Color fundus image; 2352 x 1568 pixels: 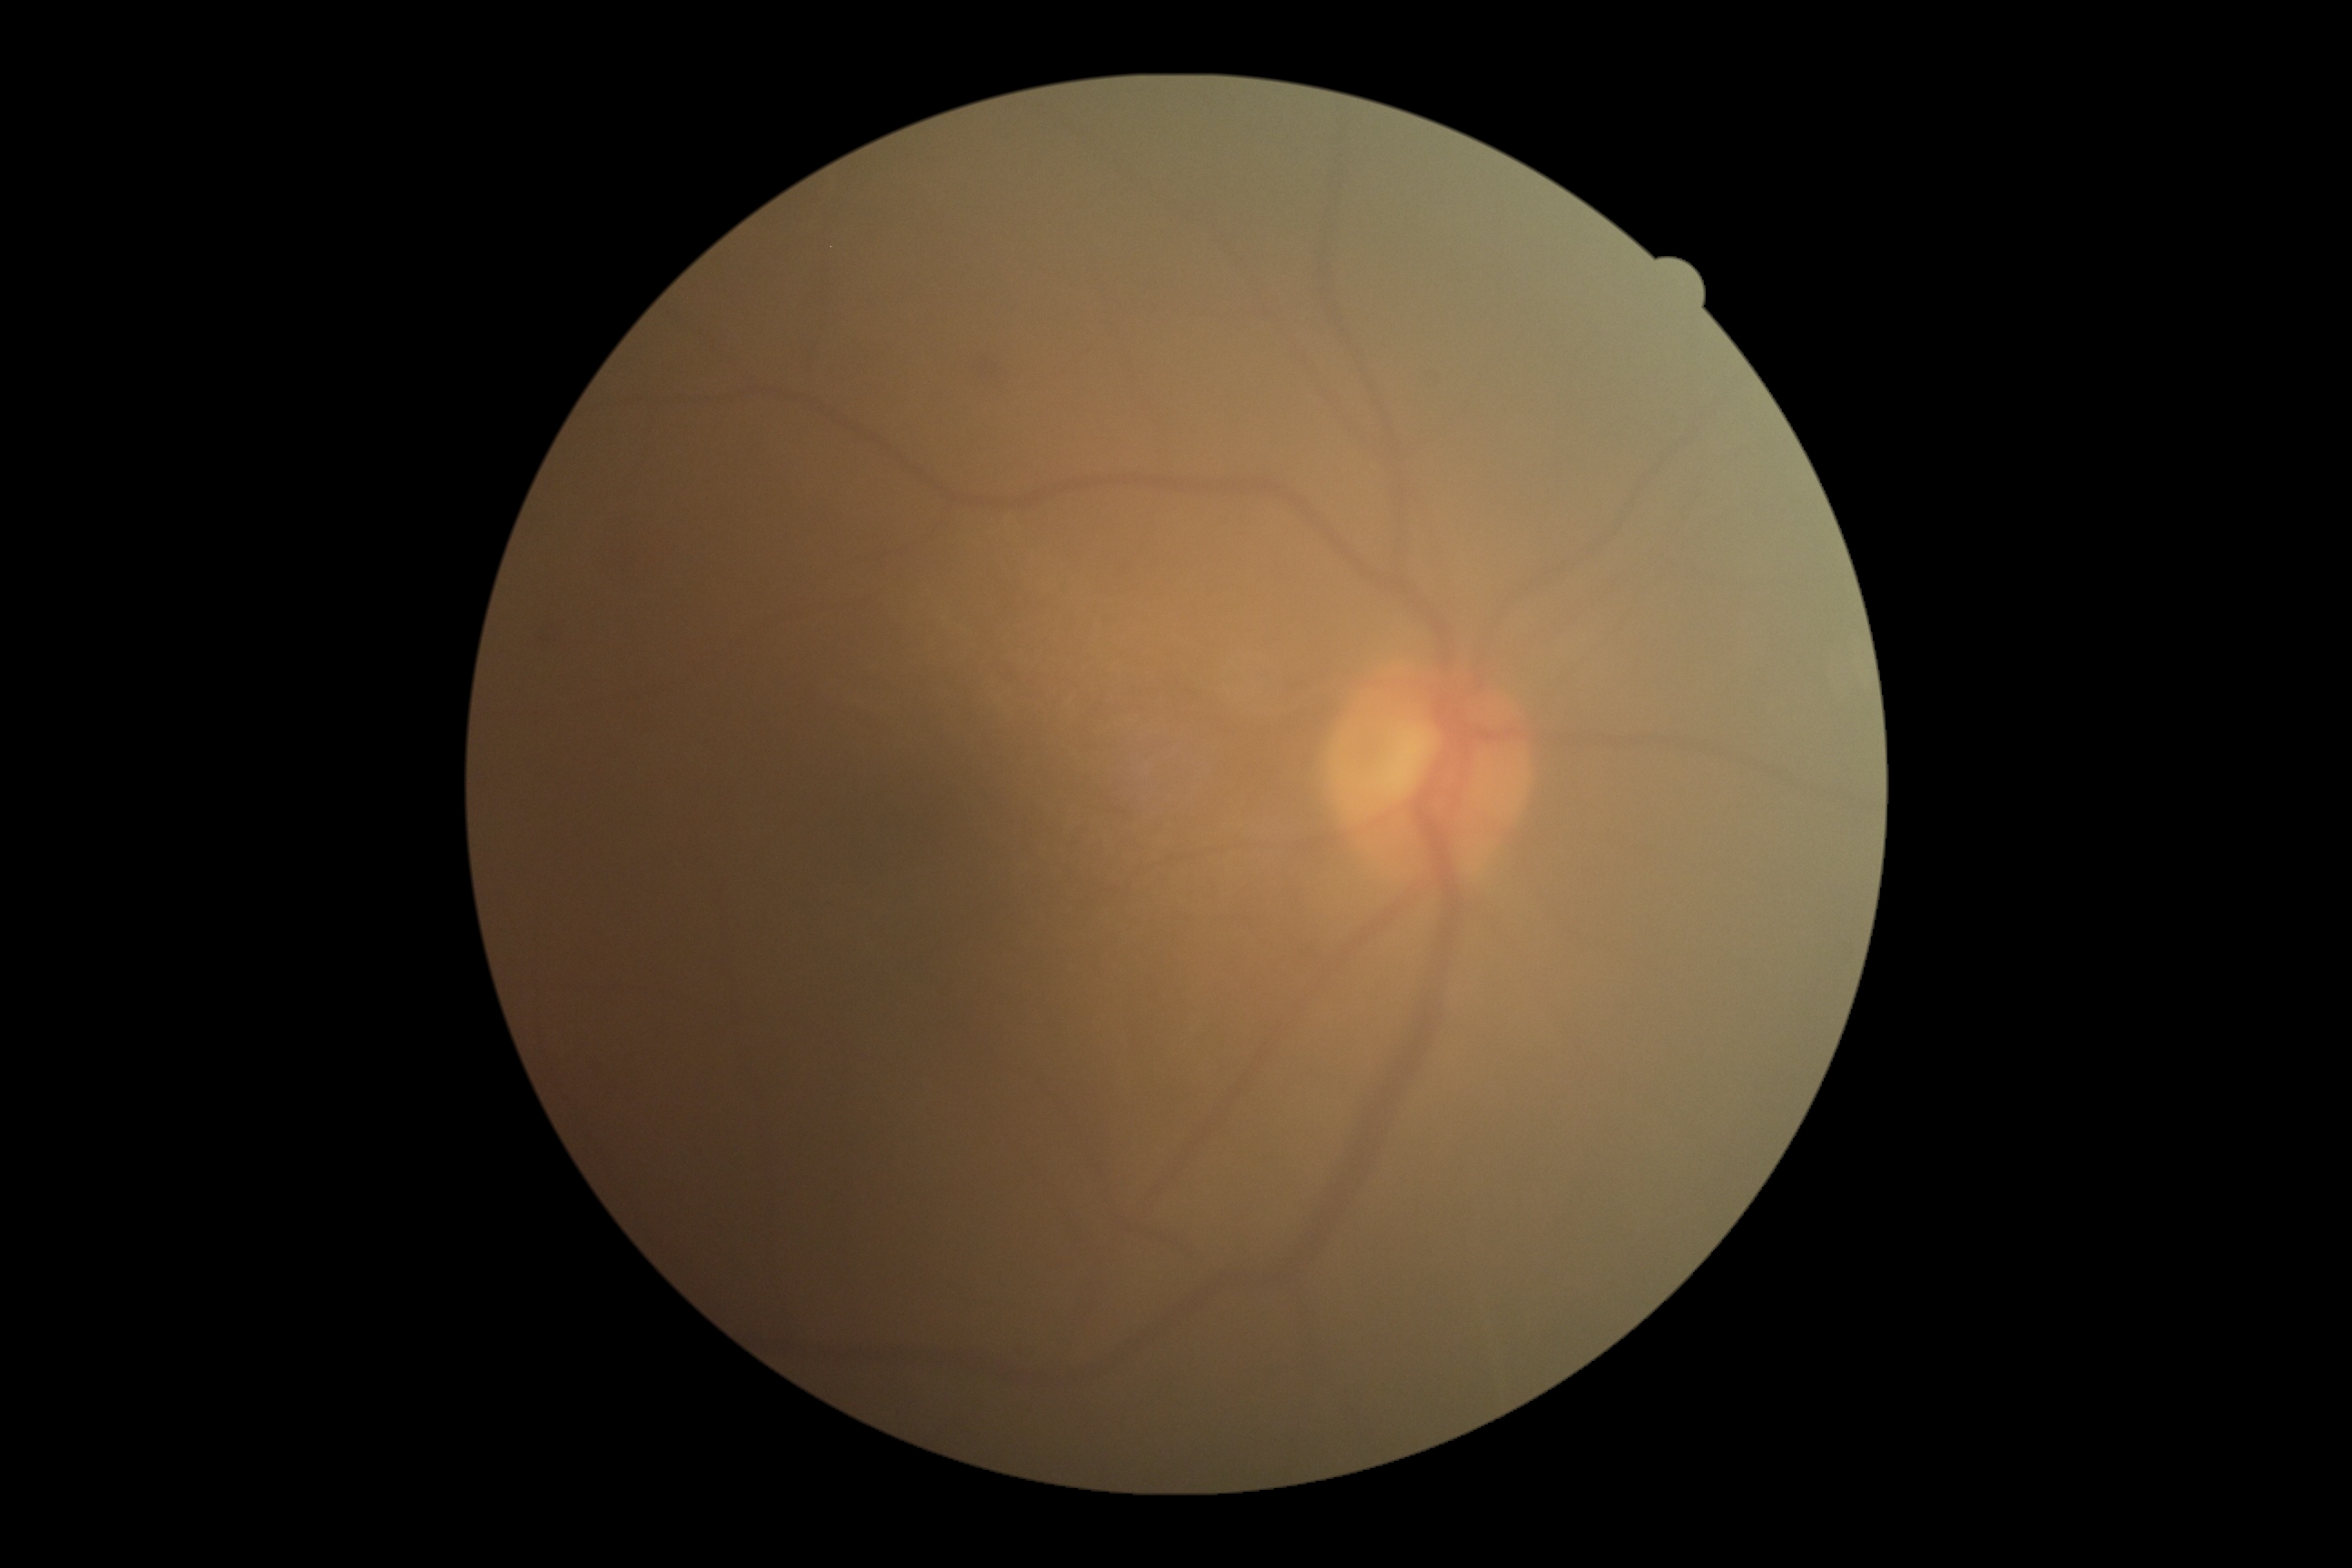

diabetic retinopathy=grade 2 (moderate NPDR).